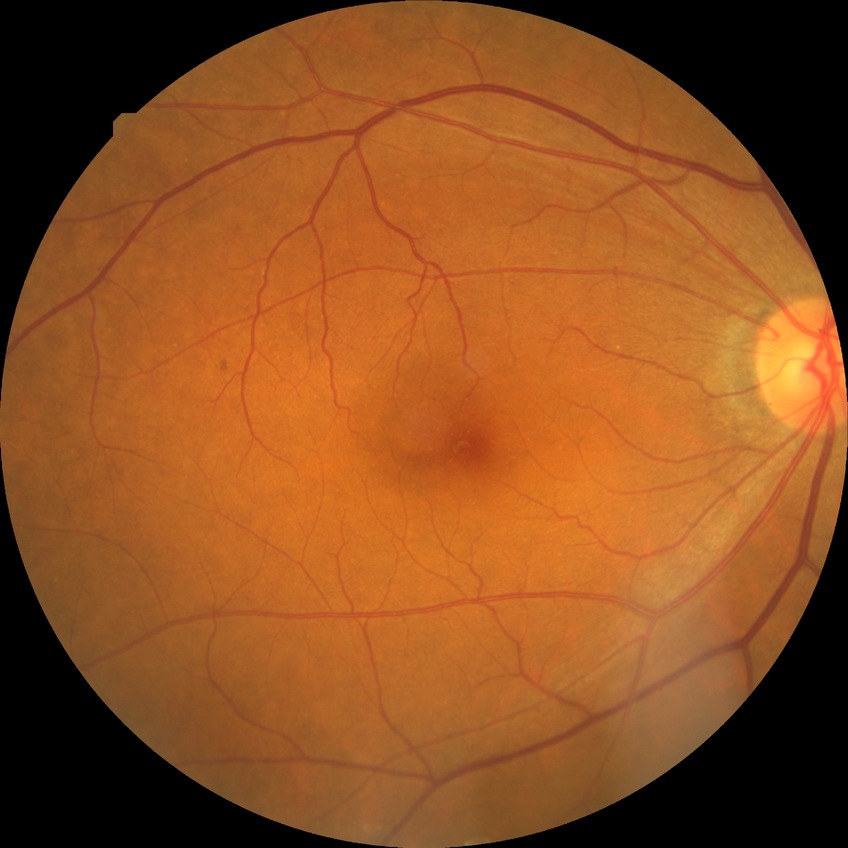
Diabetic retinopathy (DR) is no diabetic retinopathy (NDR).